1659 x 2212 pixels: 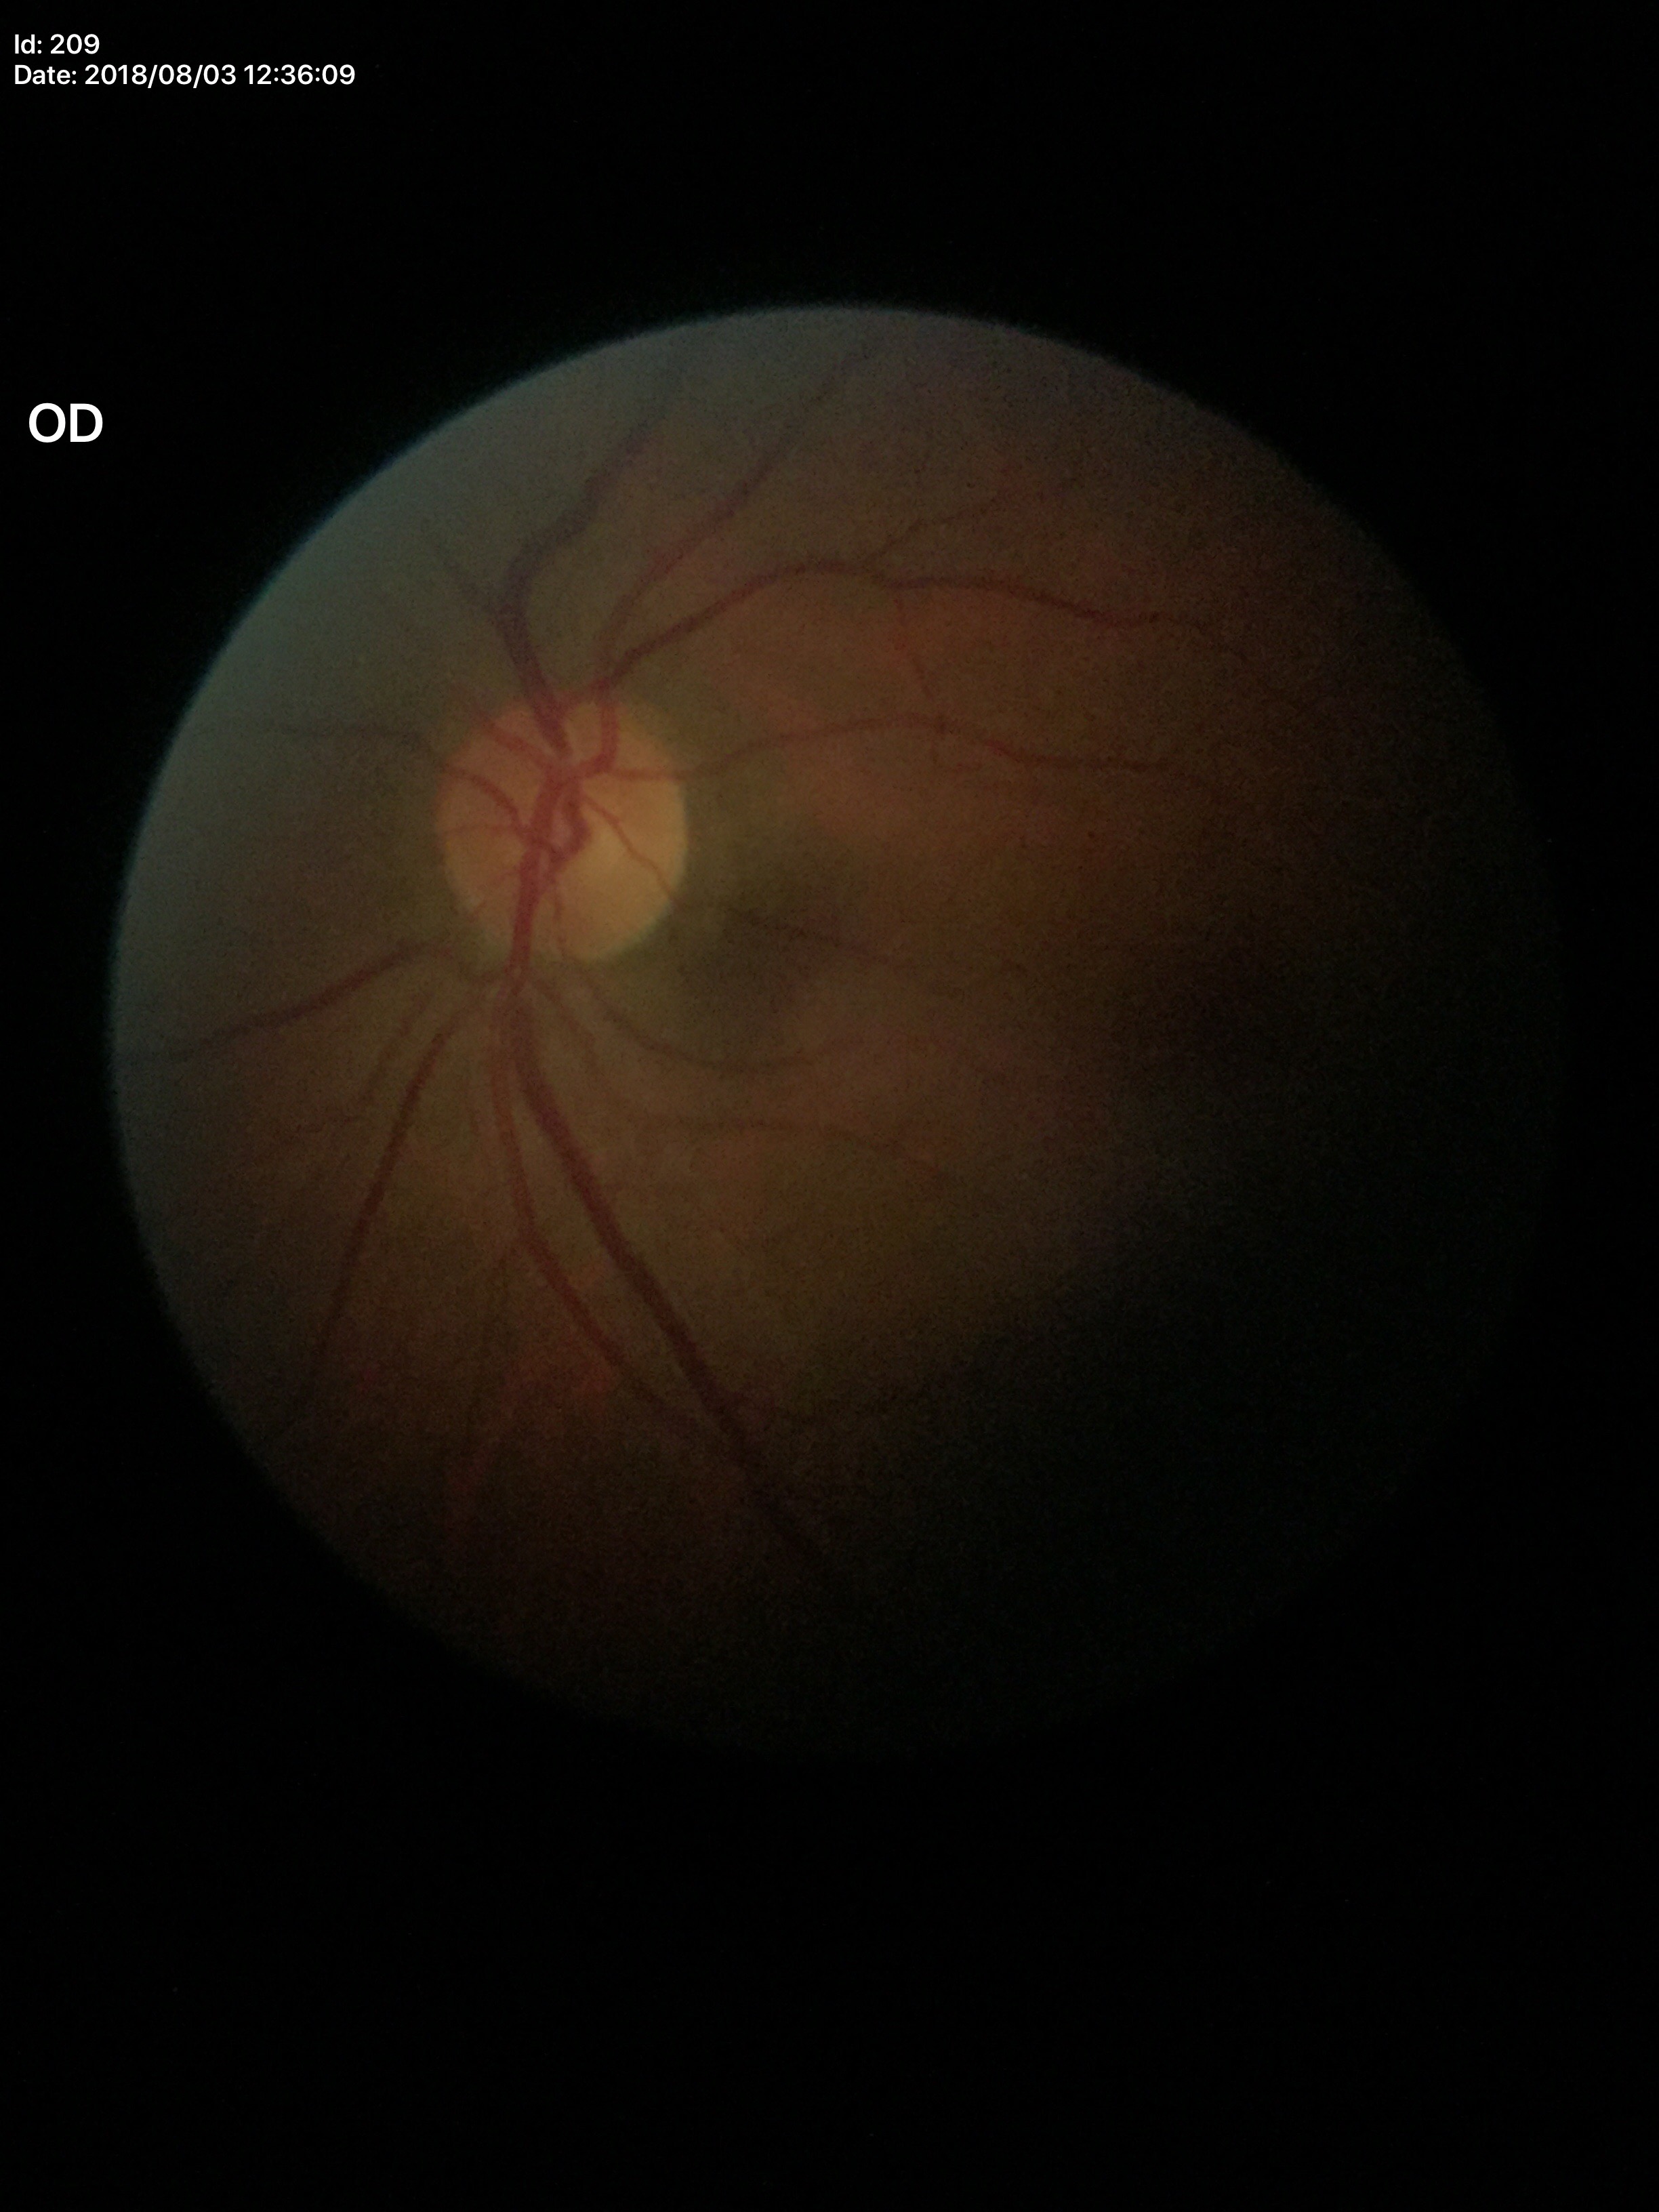
area cup-to-disc ratio: 0.24
vertical cup-disc ratio: 0.48
Glaucoma screening: not suspect